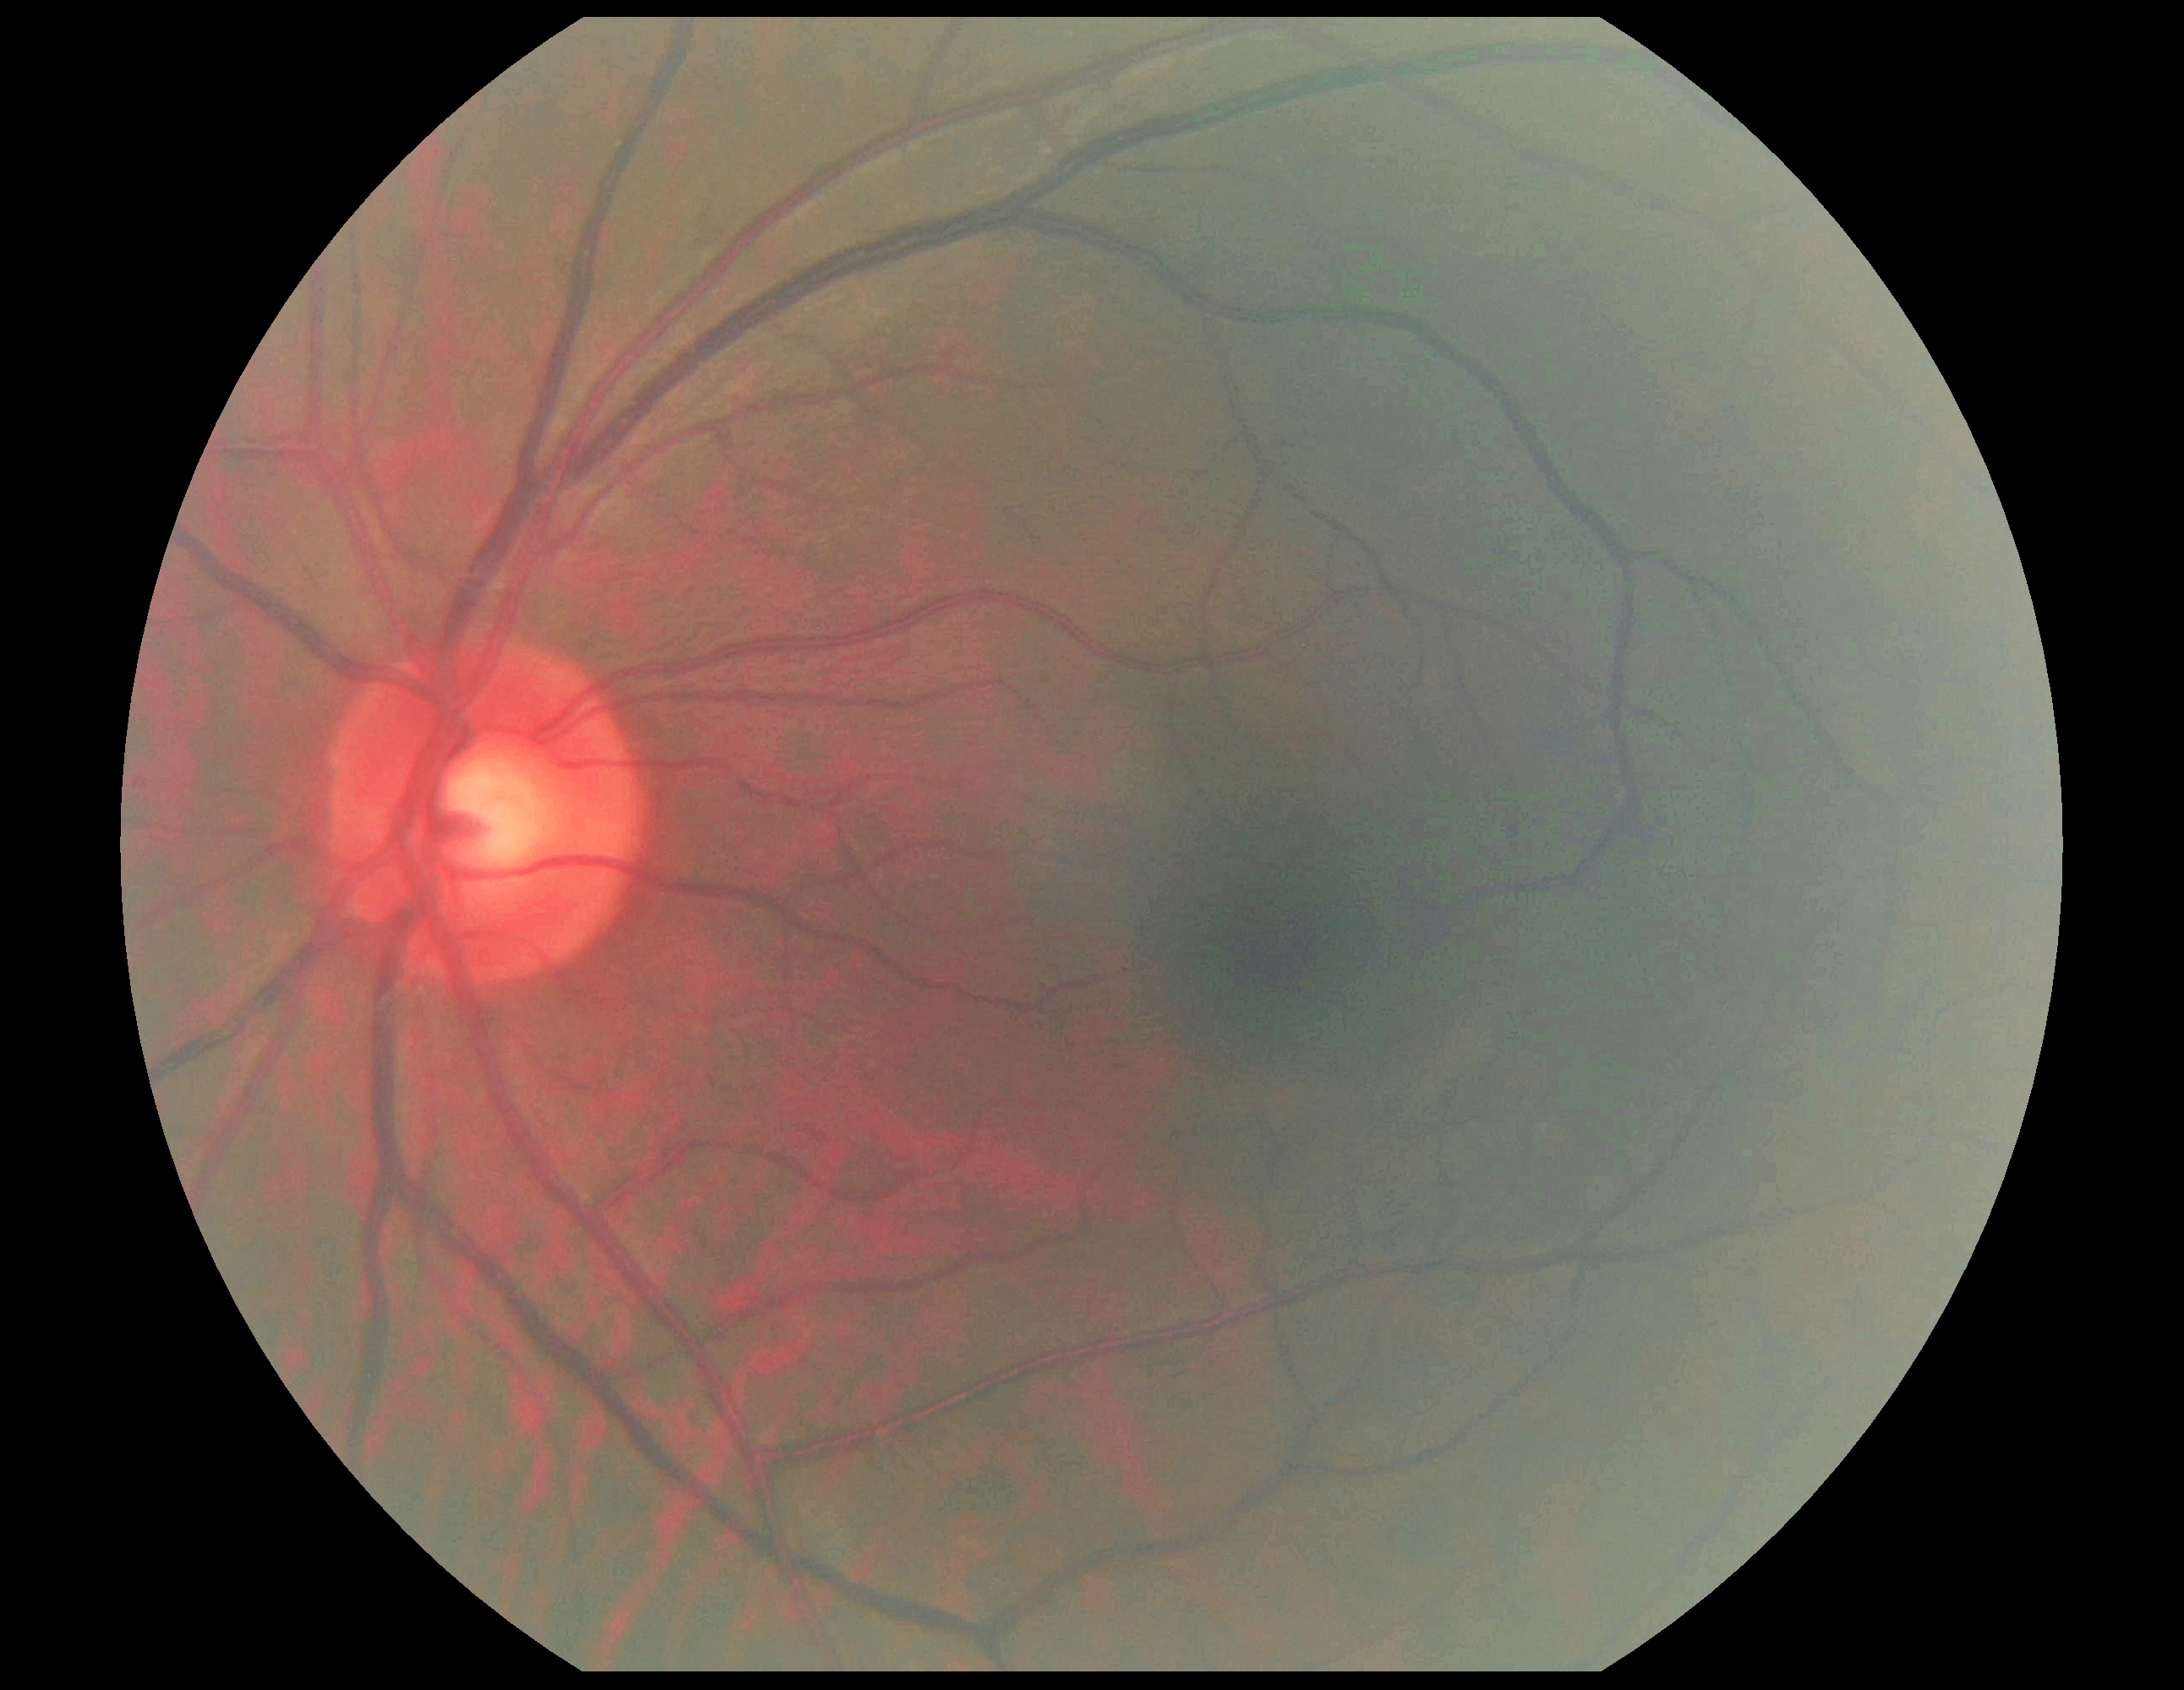

No signs of diabetic retinopathy.
DR severity is no apparent diabetic retinopathy (grade 0).